Davis DR grading; fundus photo.
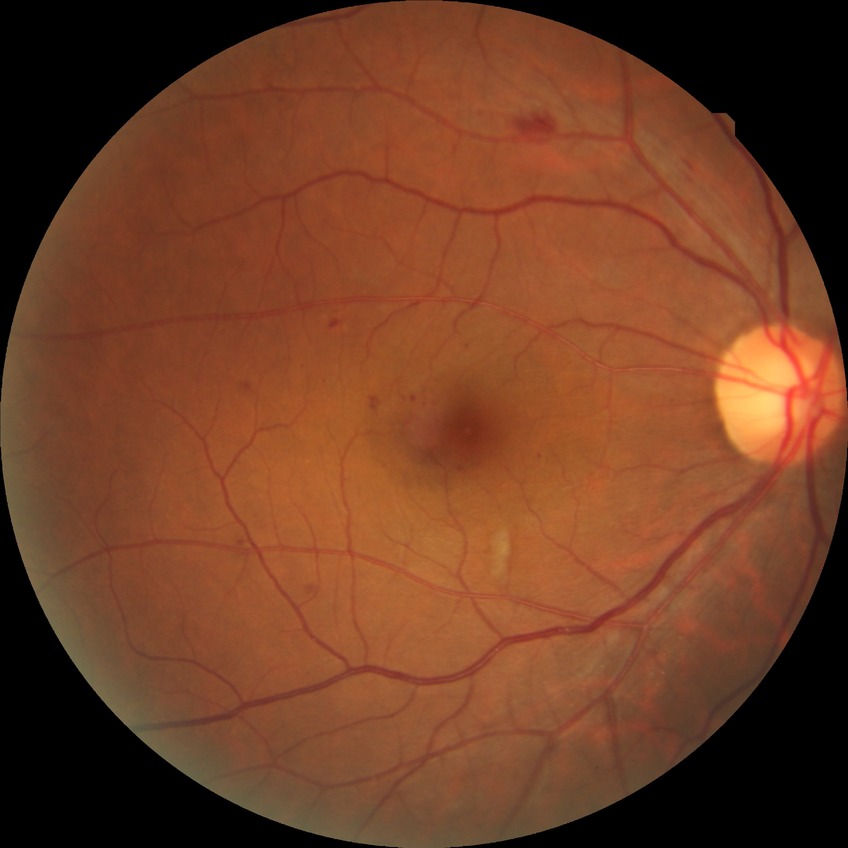 Diabetic retinopathy (DR): SDR (simple diabetic retinopathy).